Pediatric retinal photograph (wide-field):
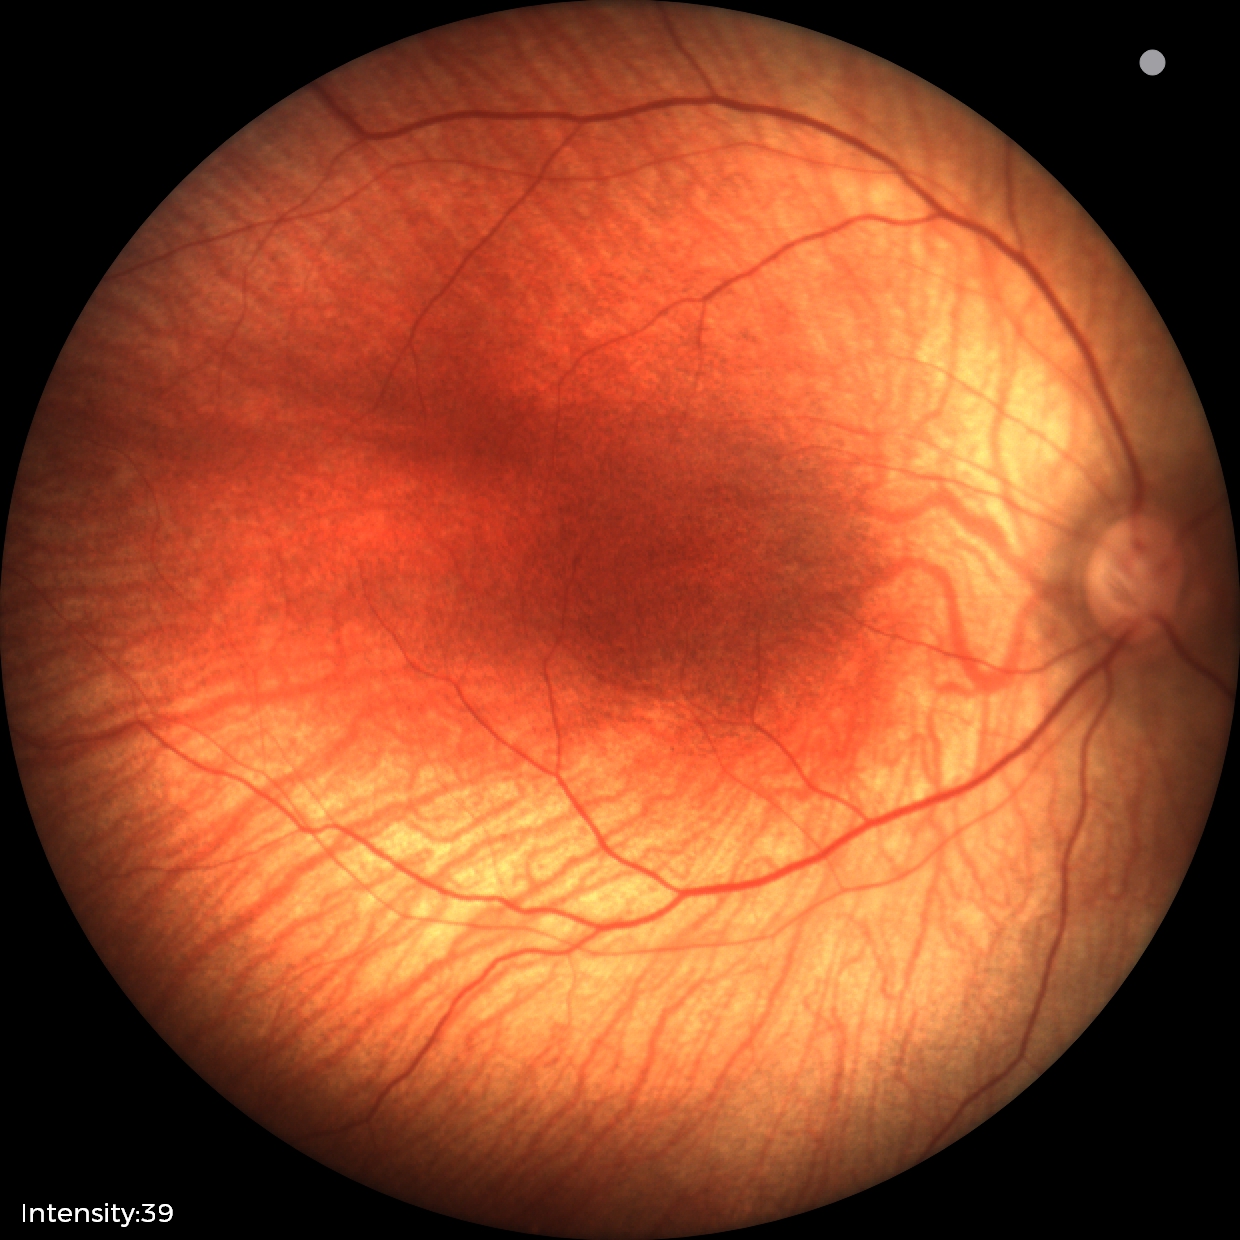

Physiological retinal appearance for postconceptual age.